Camera: Topcon TRC-NW8 · 1932x1932 · 50-degree field of view
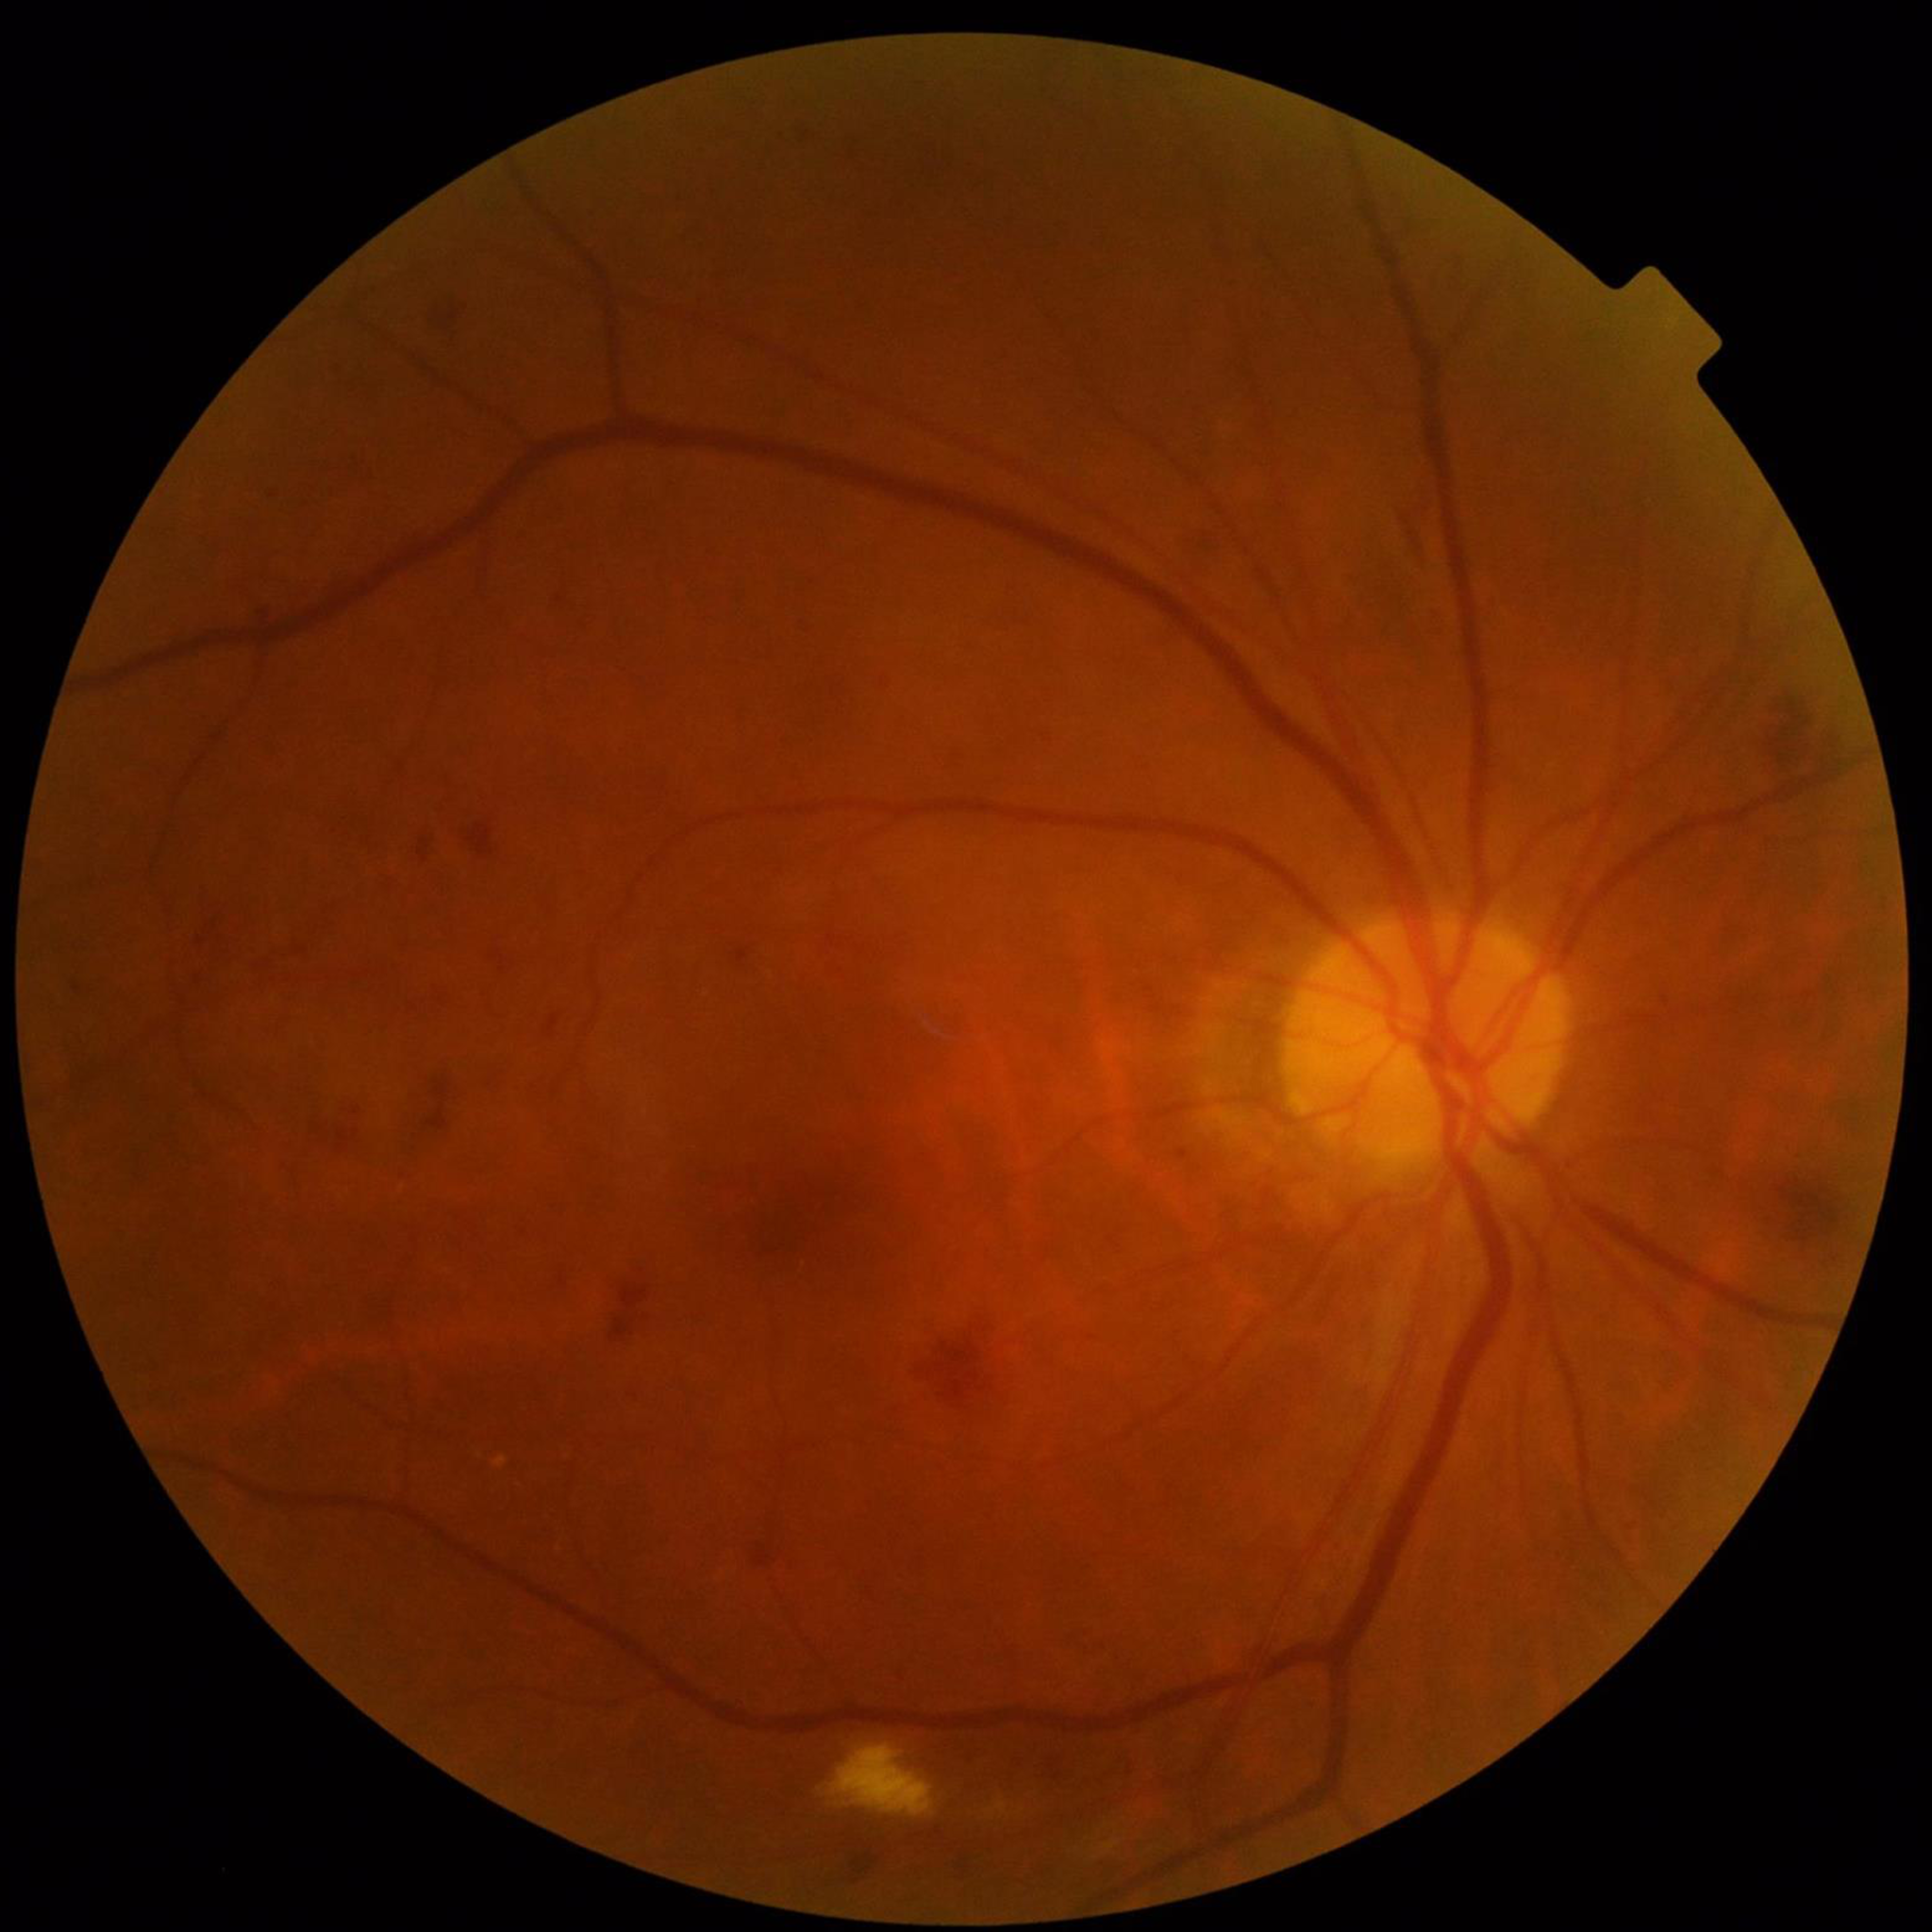

Impression: DR